Image size 1380x1382: 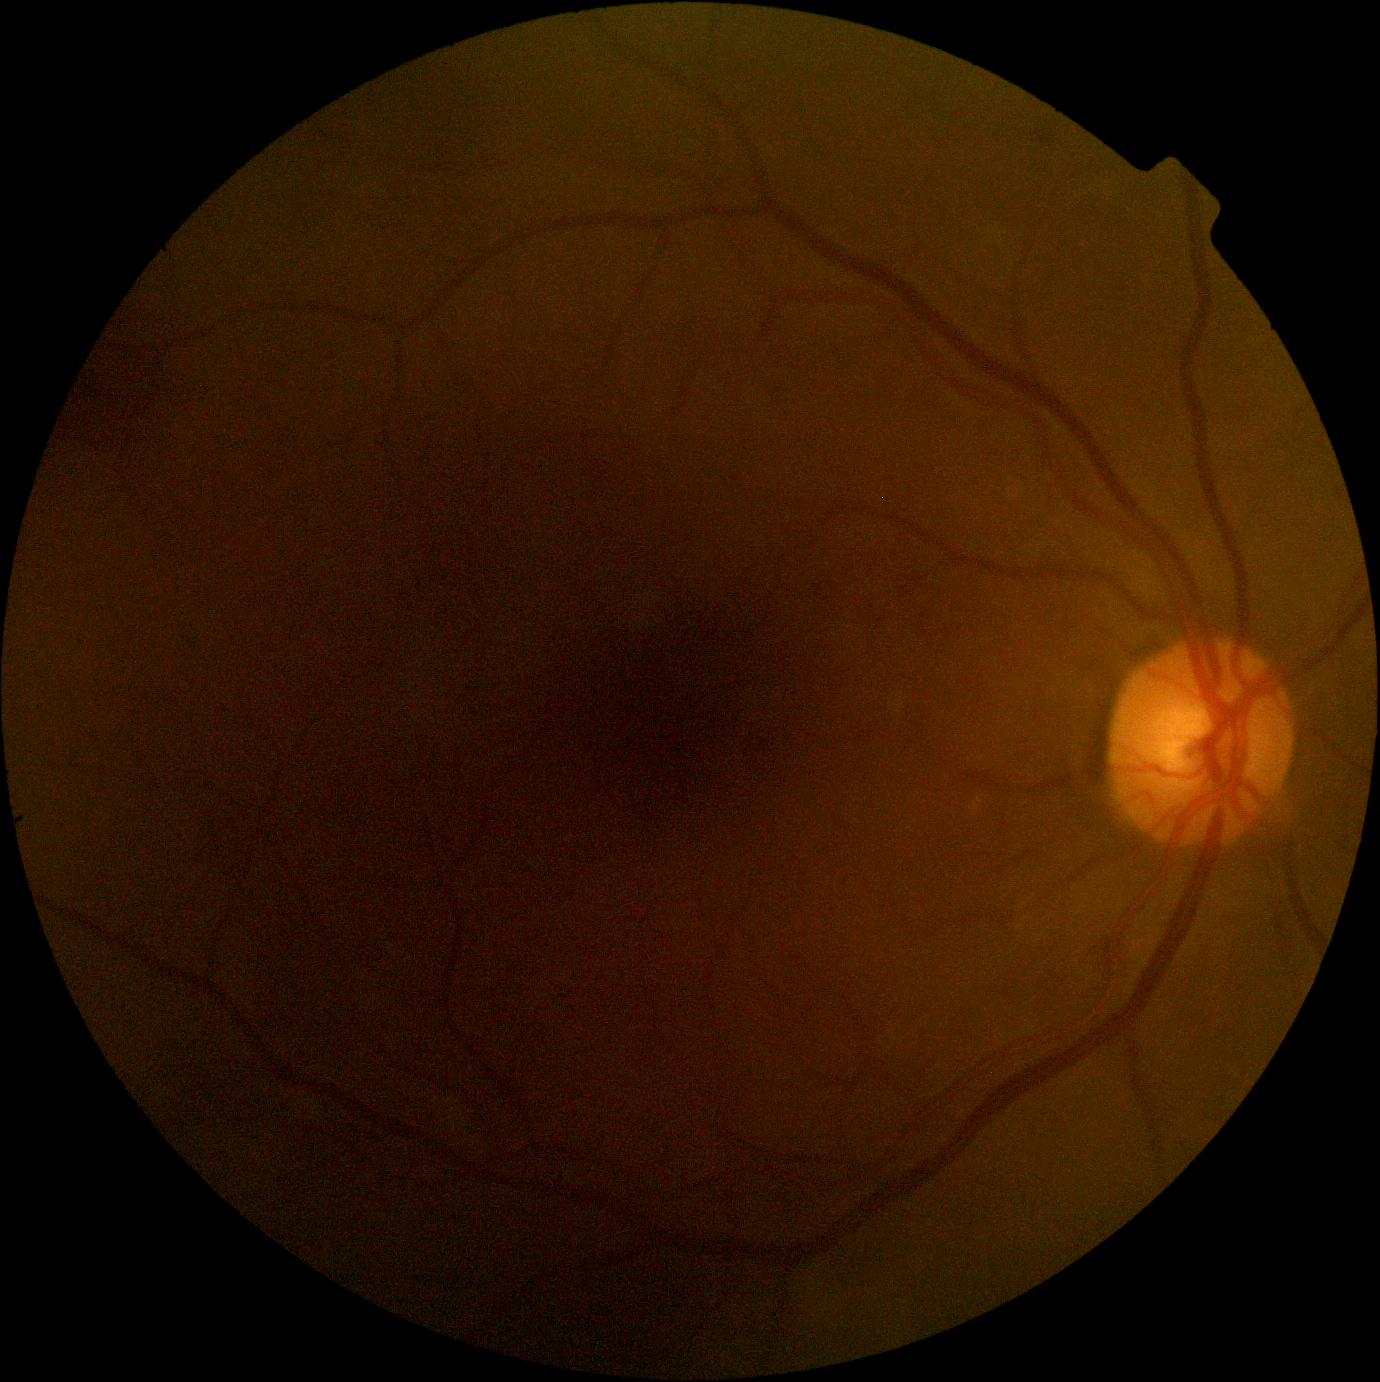

Diabetic retinopathy: 2/4.